Wide-field fundus photograph of an infant · camera: Phoenix ICON (100° FOV): 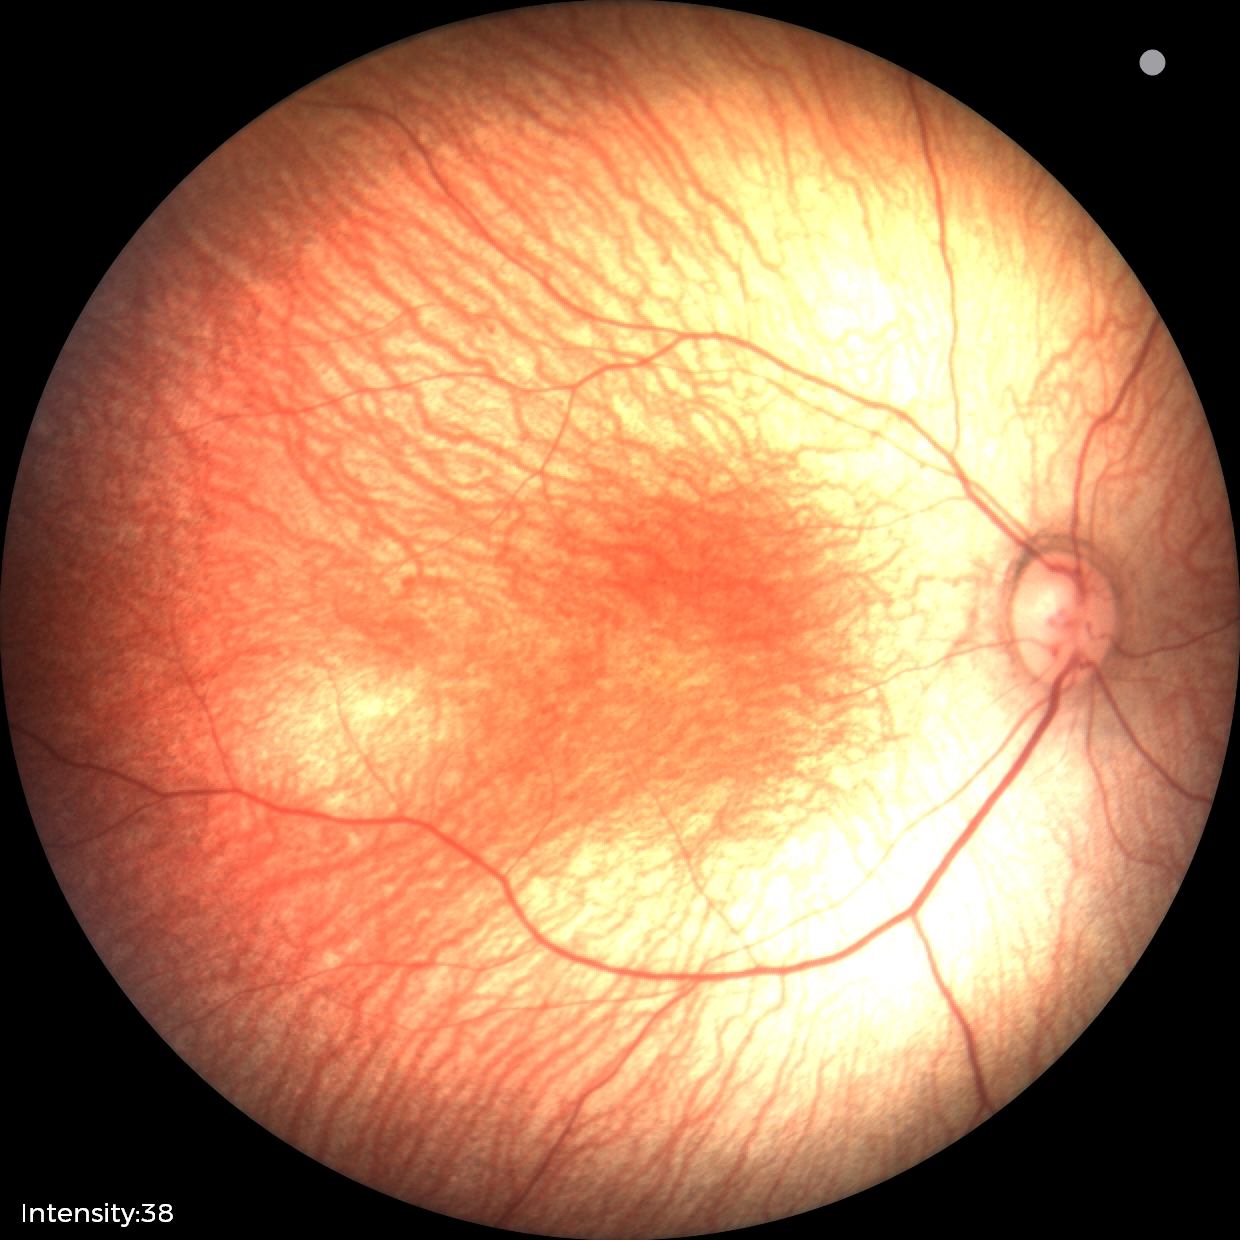

Normal screening examination.